1970x1876.
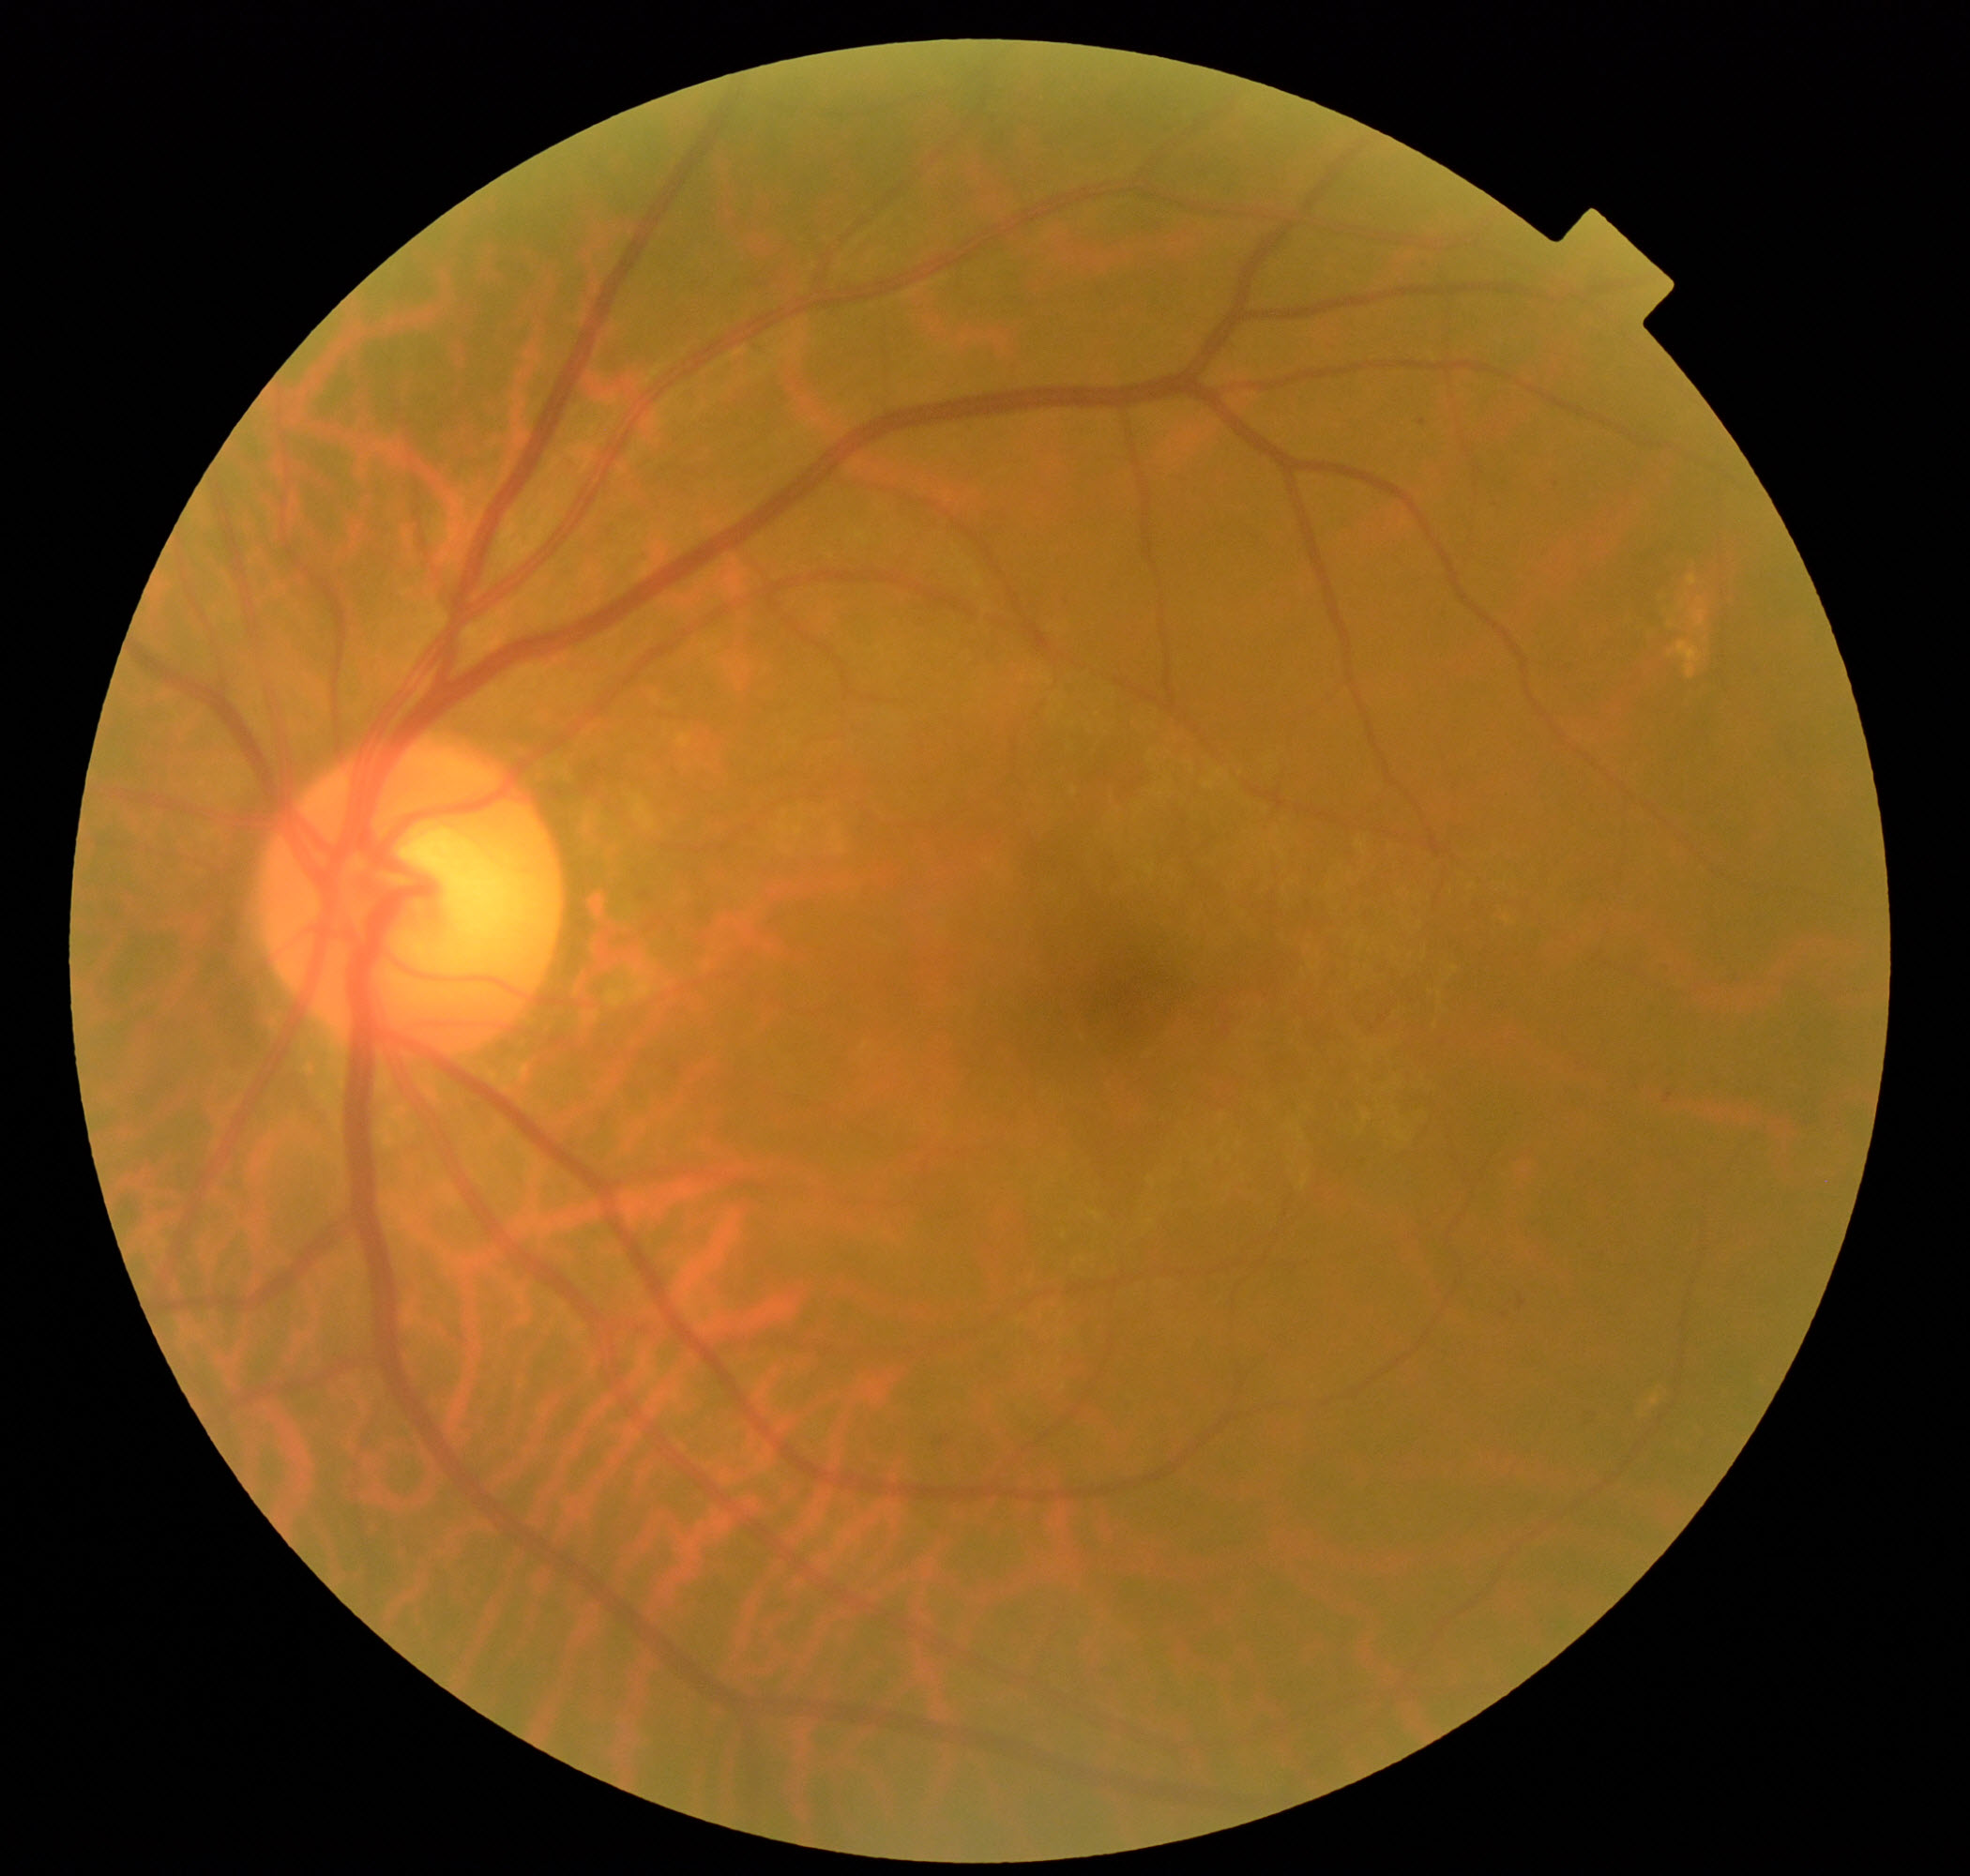

Primary finding: epiretinal membrane.